Image size 2048x1536 — 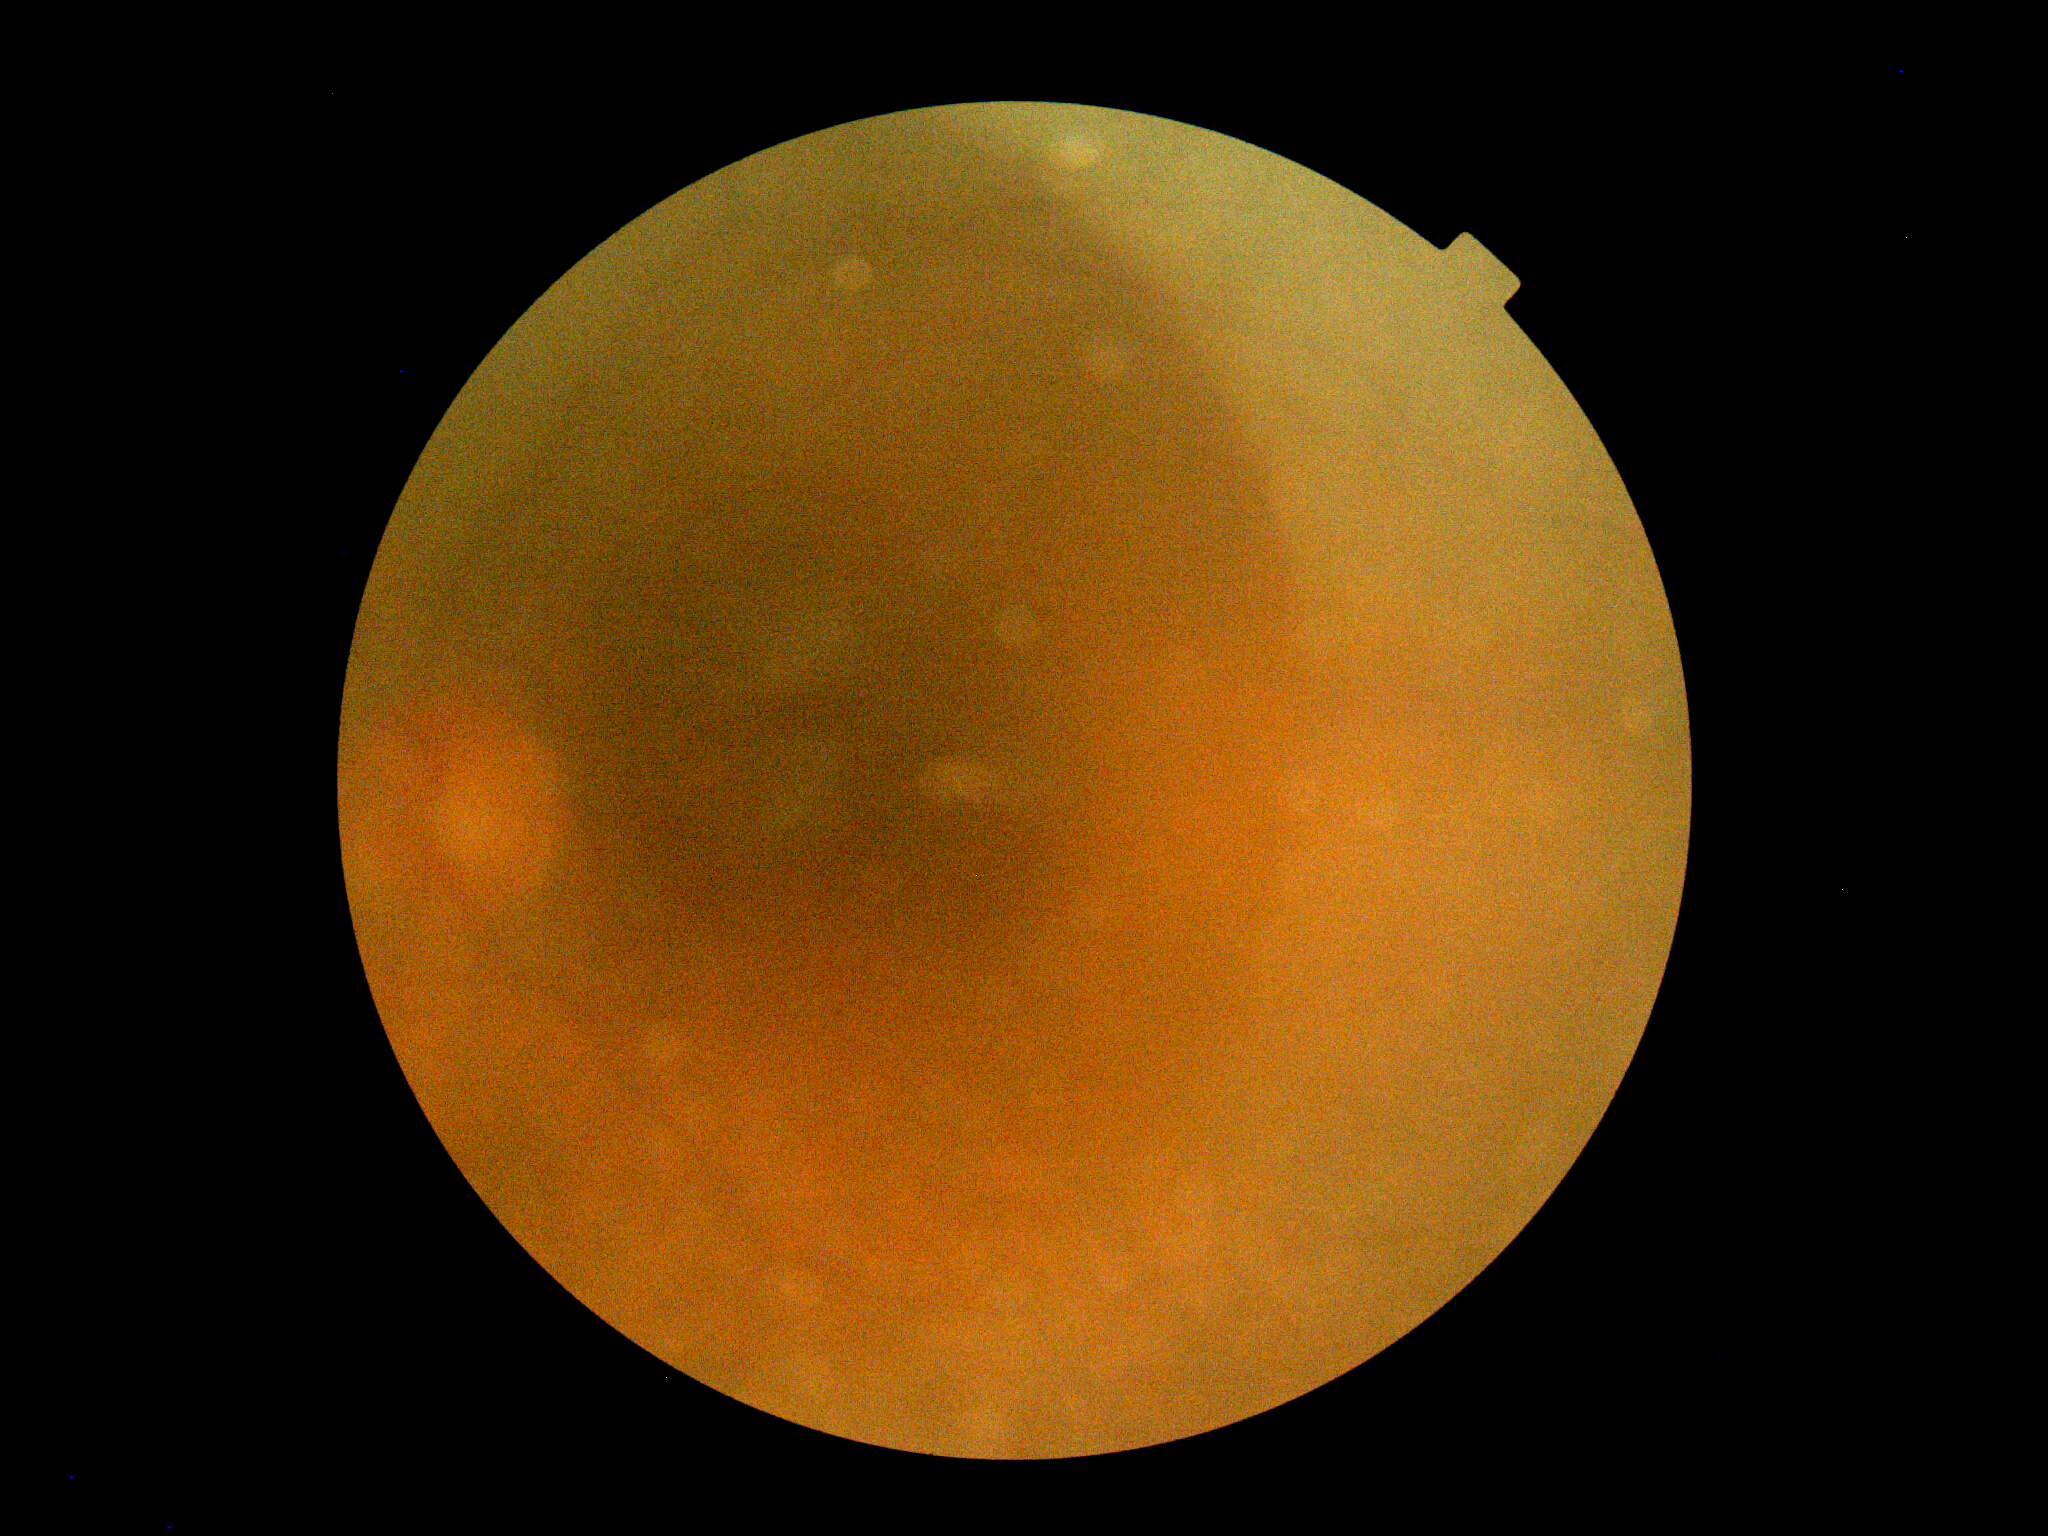

Findings:
– retinopathy grade — ungradable
– image quality — insufficient for DR assessment